Wide-field fundus image from infant ROP screening · 1440x1080: 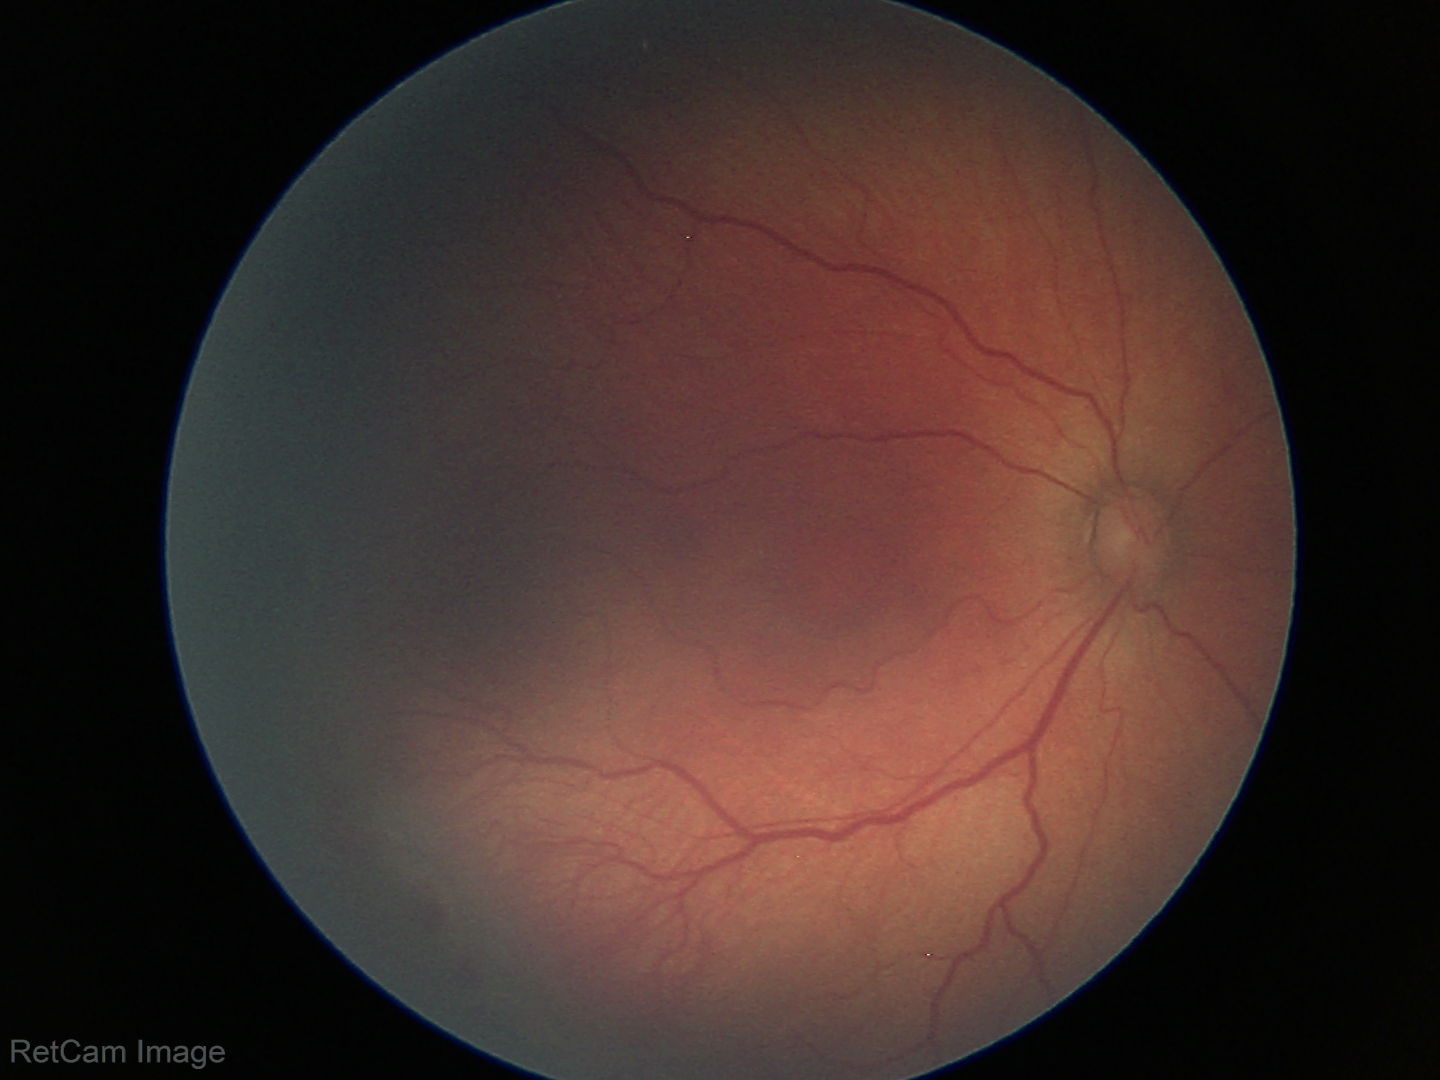
Without plus disease. Diagnosis from this screening exam: retinopathy of prematurity (ROP) stage 2.